FOV: 45 degrees. No pharmacologic dilation — 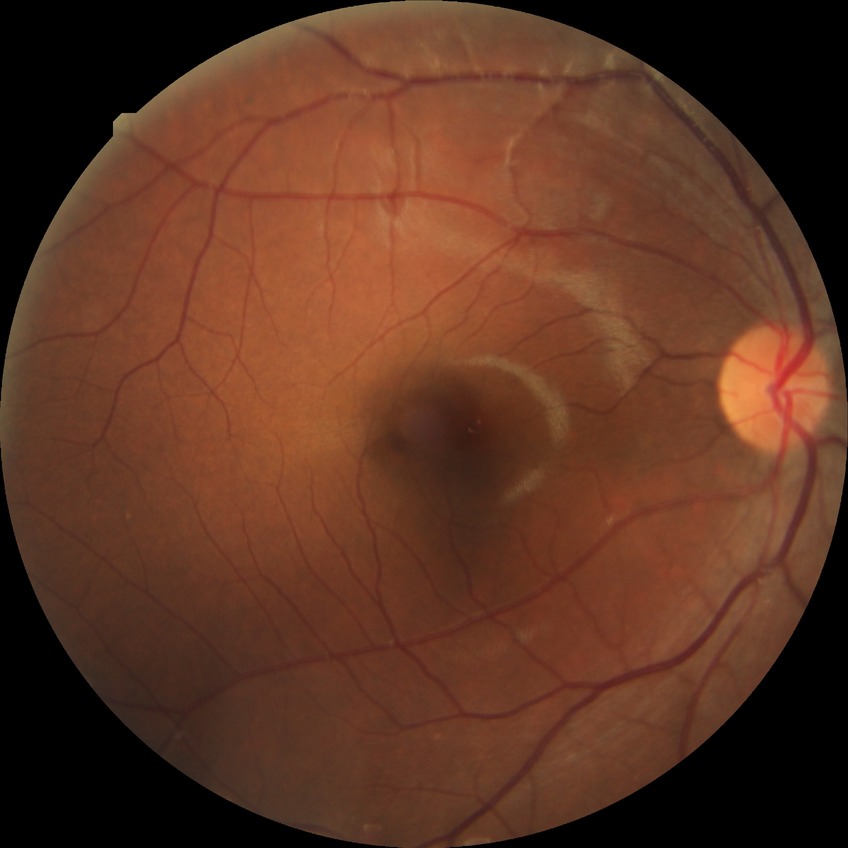
Davis grading: no diabetic retinopathy